Retinal fundus photograph — 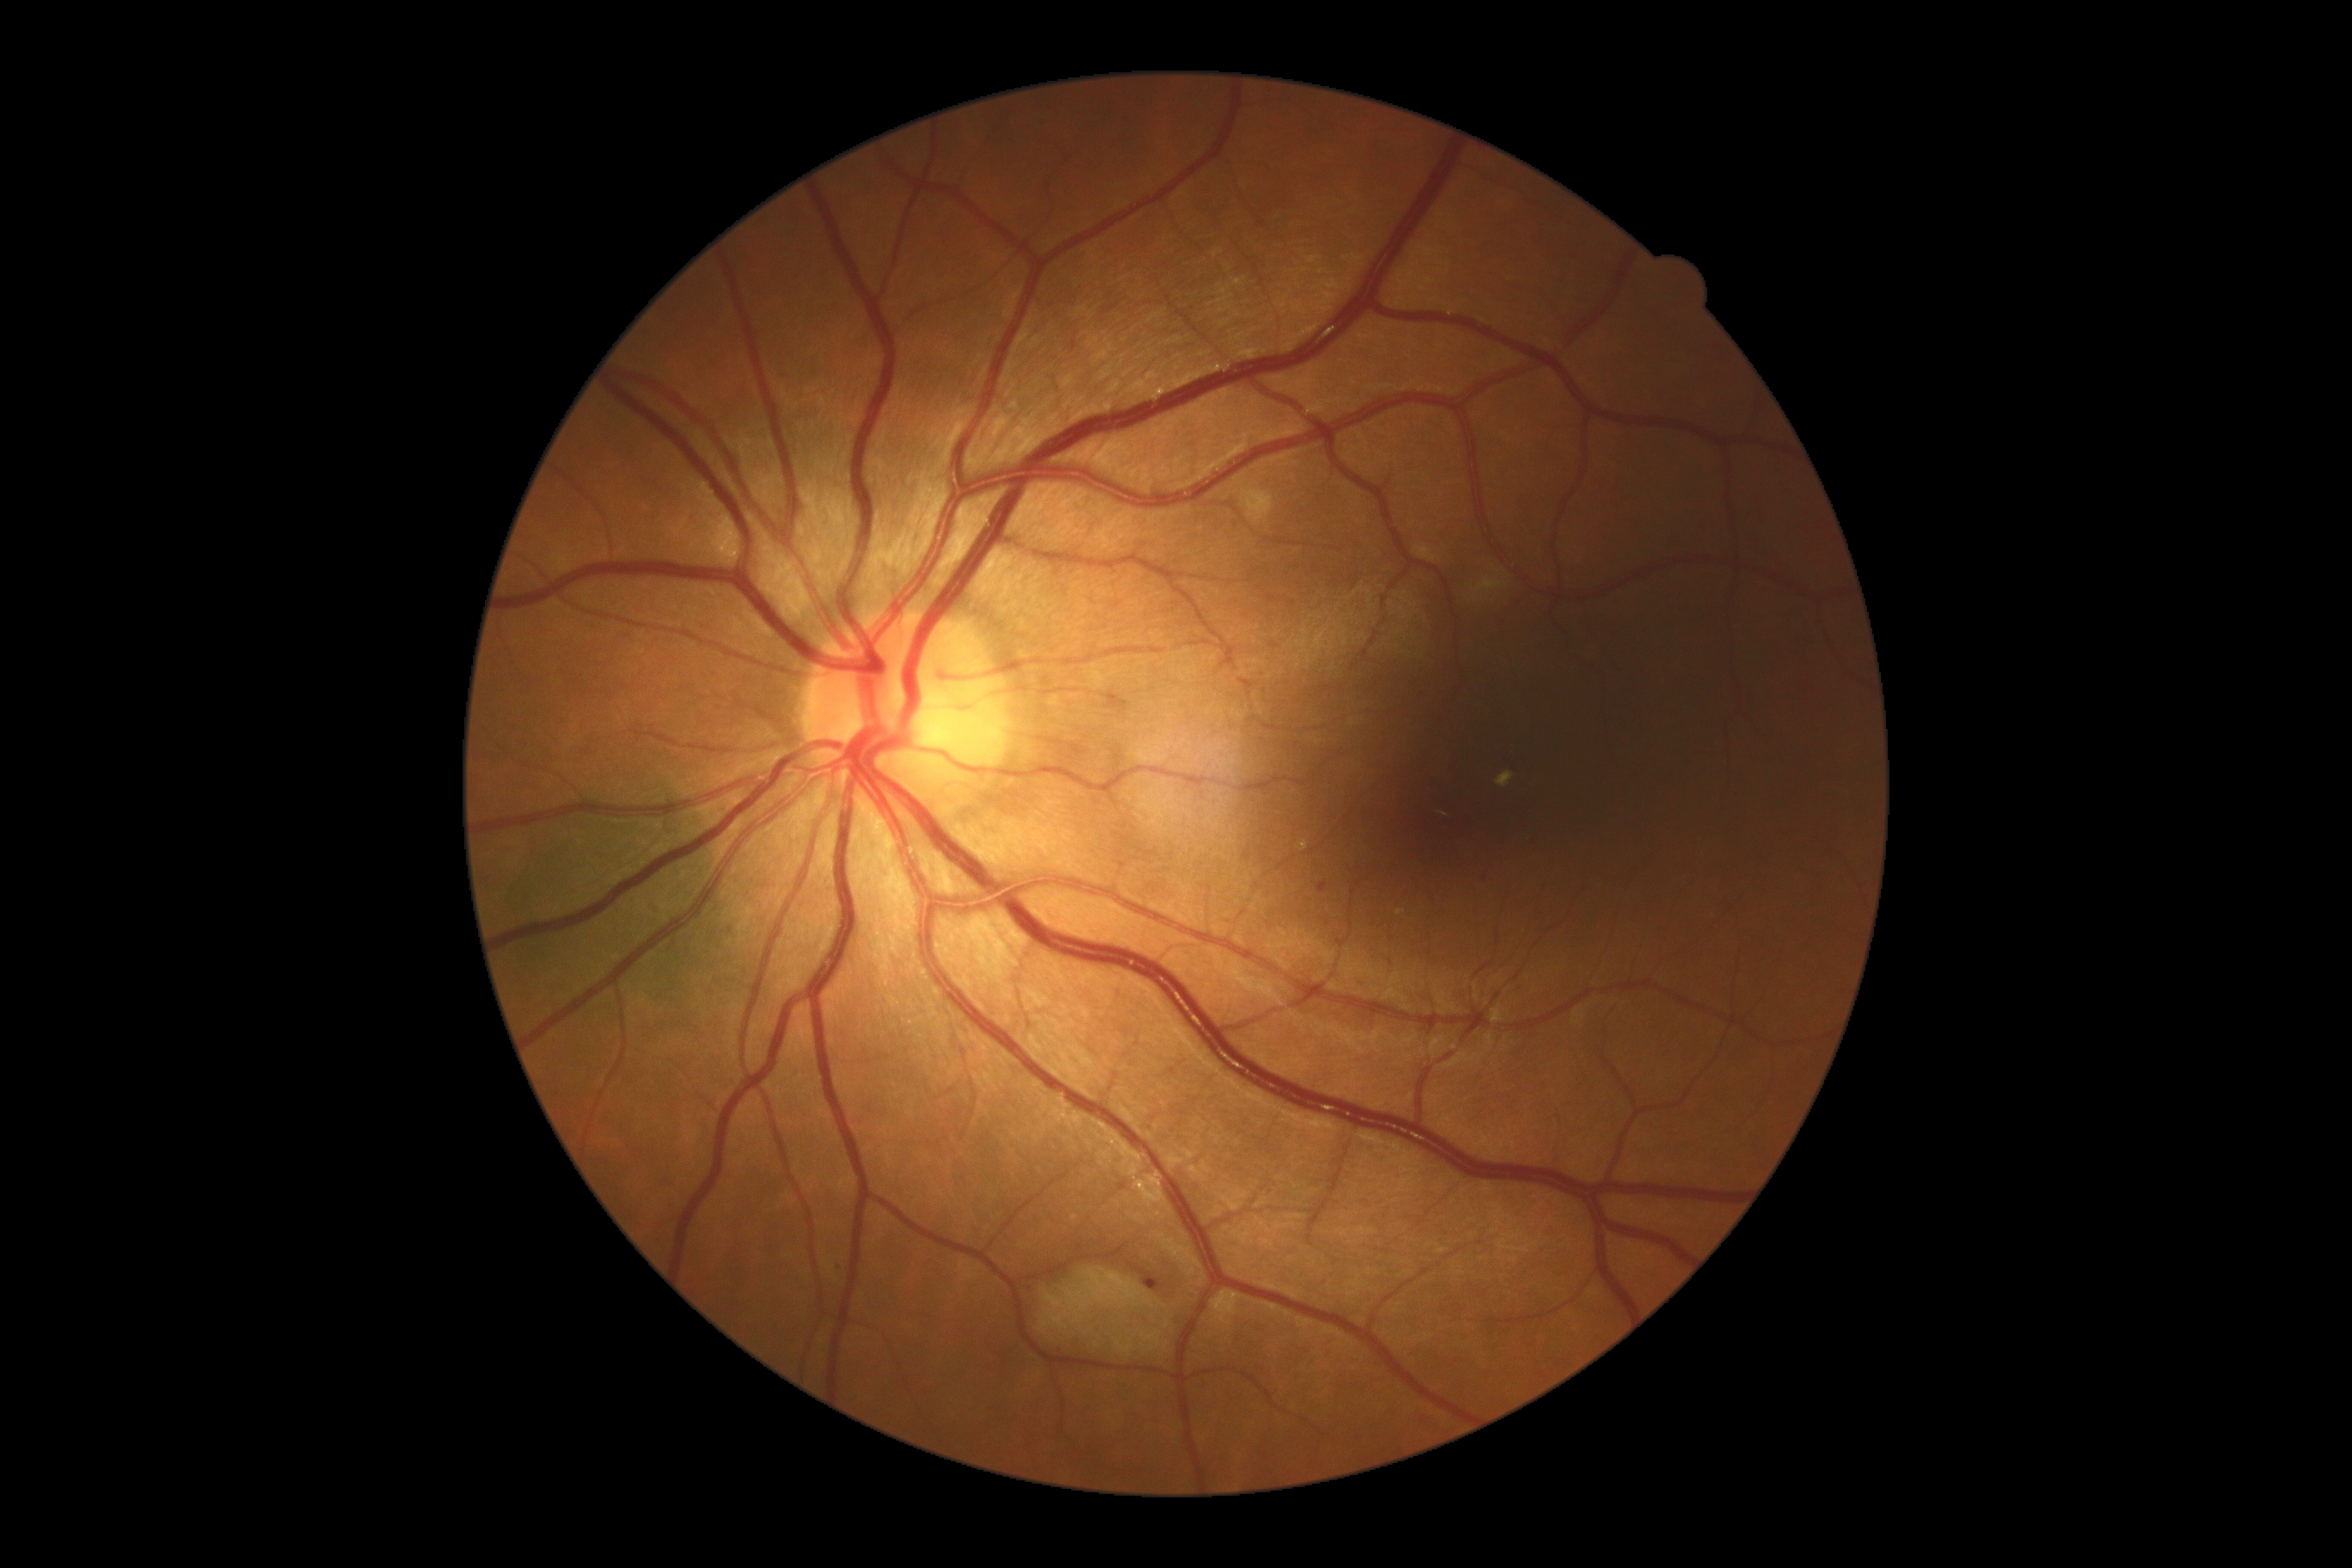
diabetic retinopathy (DR)@2.